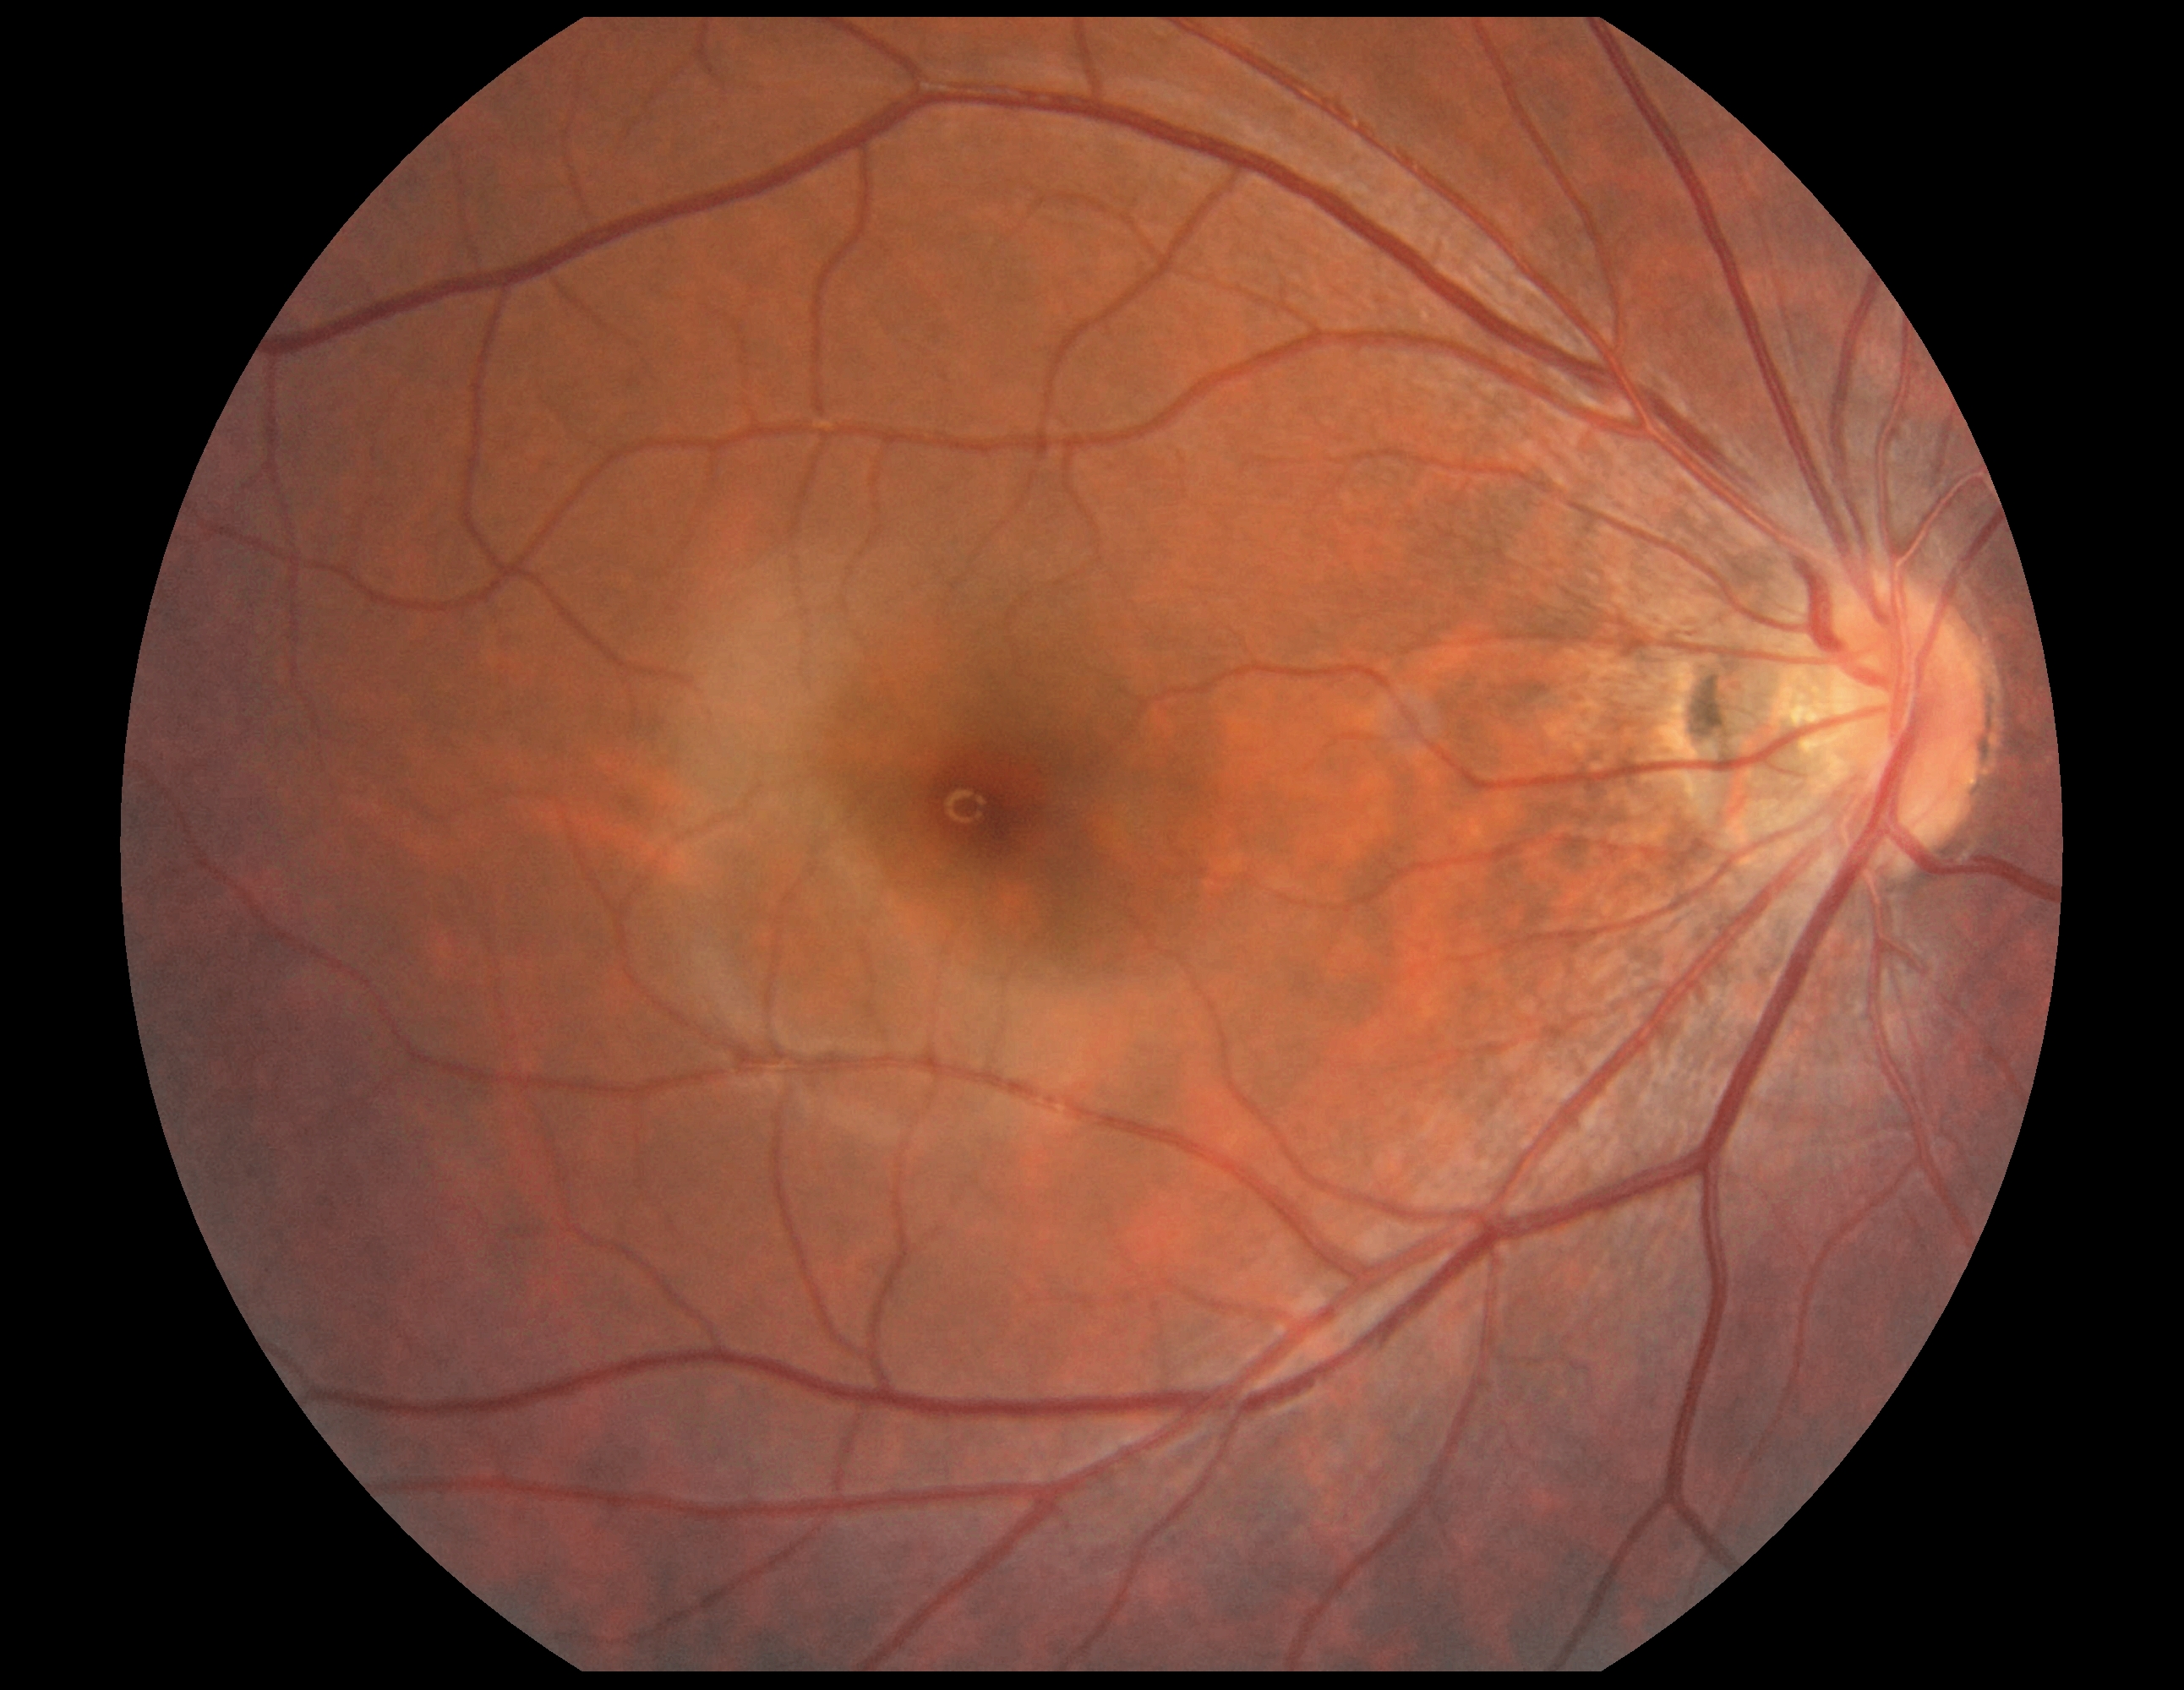
Diabetic retinopathy grade is 0 (no apparent retinopathy).